45° FOV. 1932 x 1916 pixels — 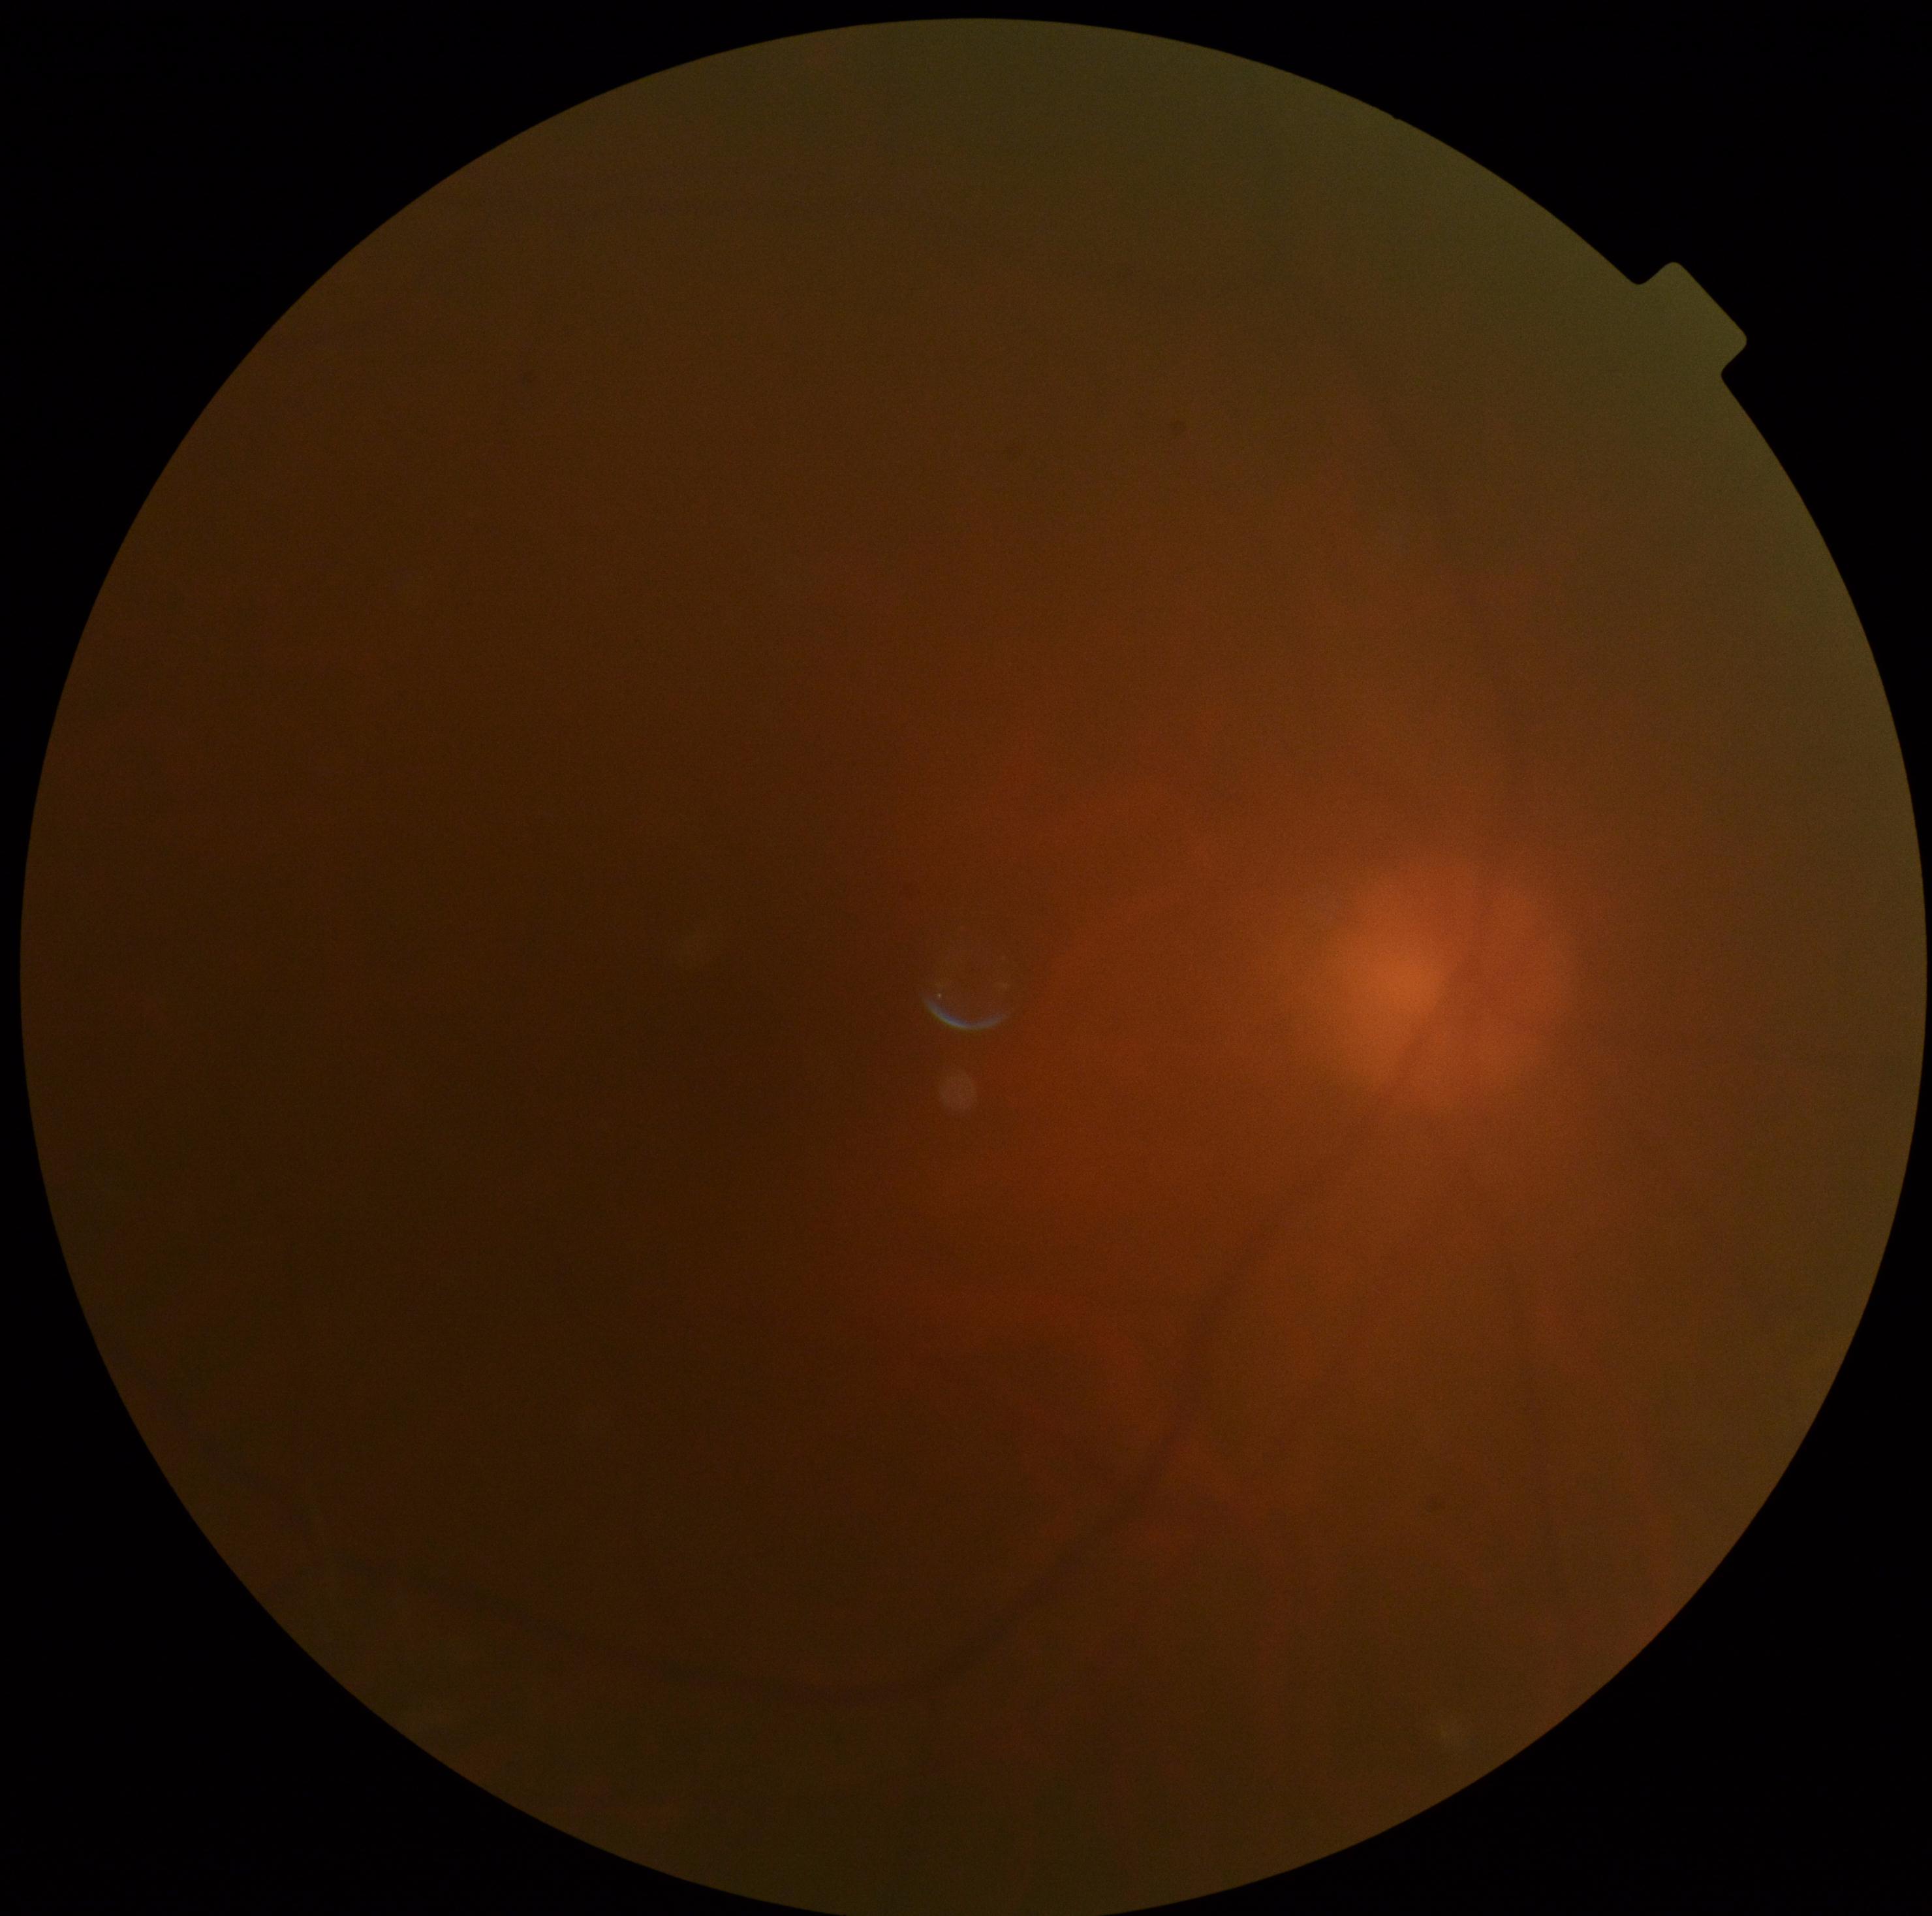 Diabetic retinopathy grade: ungradable.